CFP; graded on the modified Davis scale; NIDEK AFC-230 fundus camera; FOV: 45 degrees; no pharmacologic dilation; 848x848
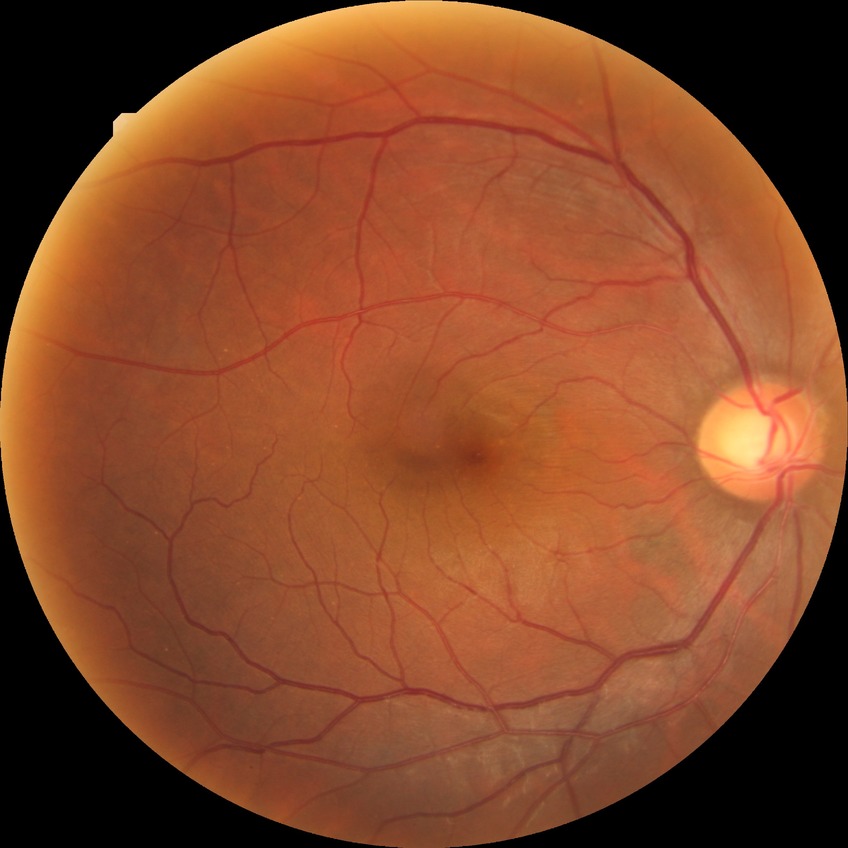
No signs of diabetic retinopathy. Davis DR grade: NDR.